1932 by 1910 pixels: 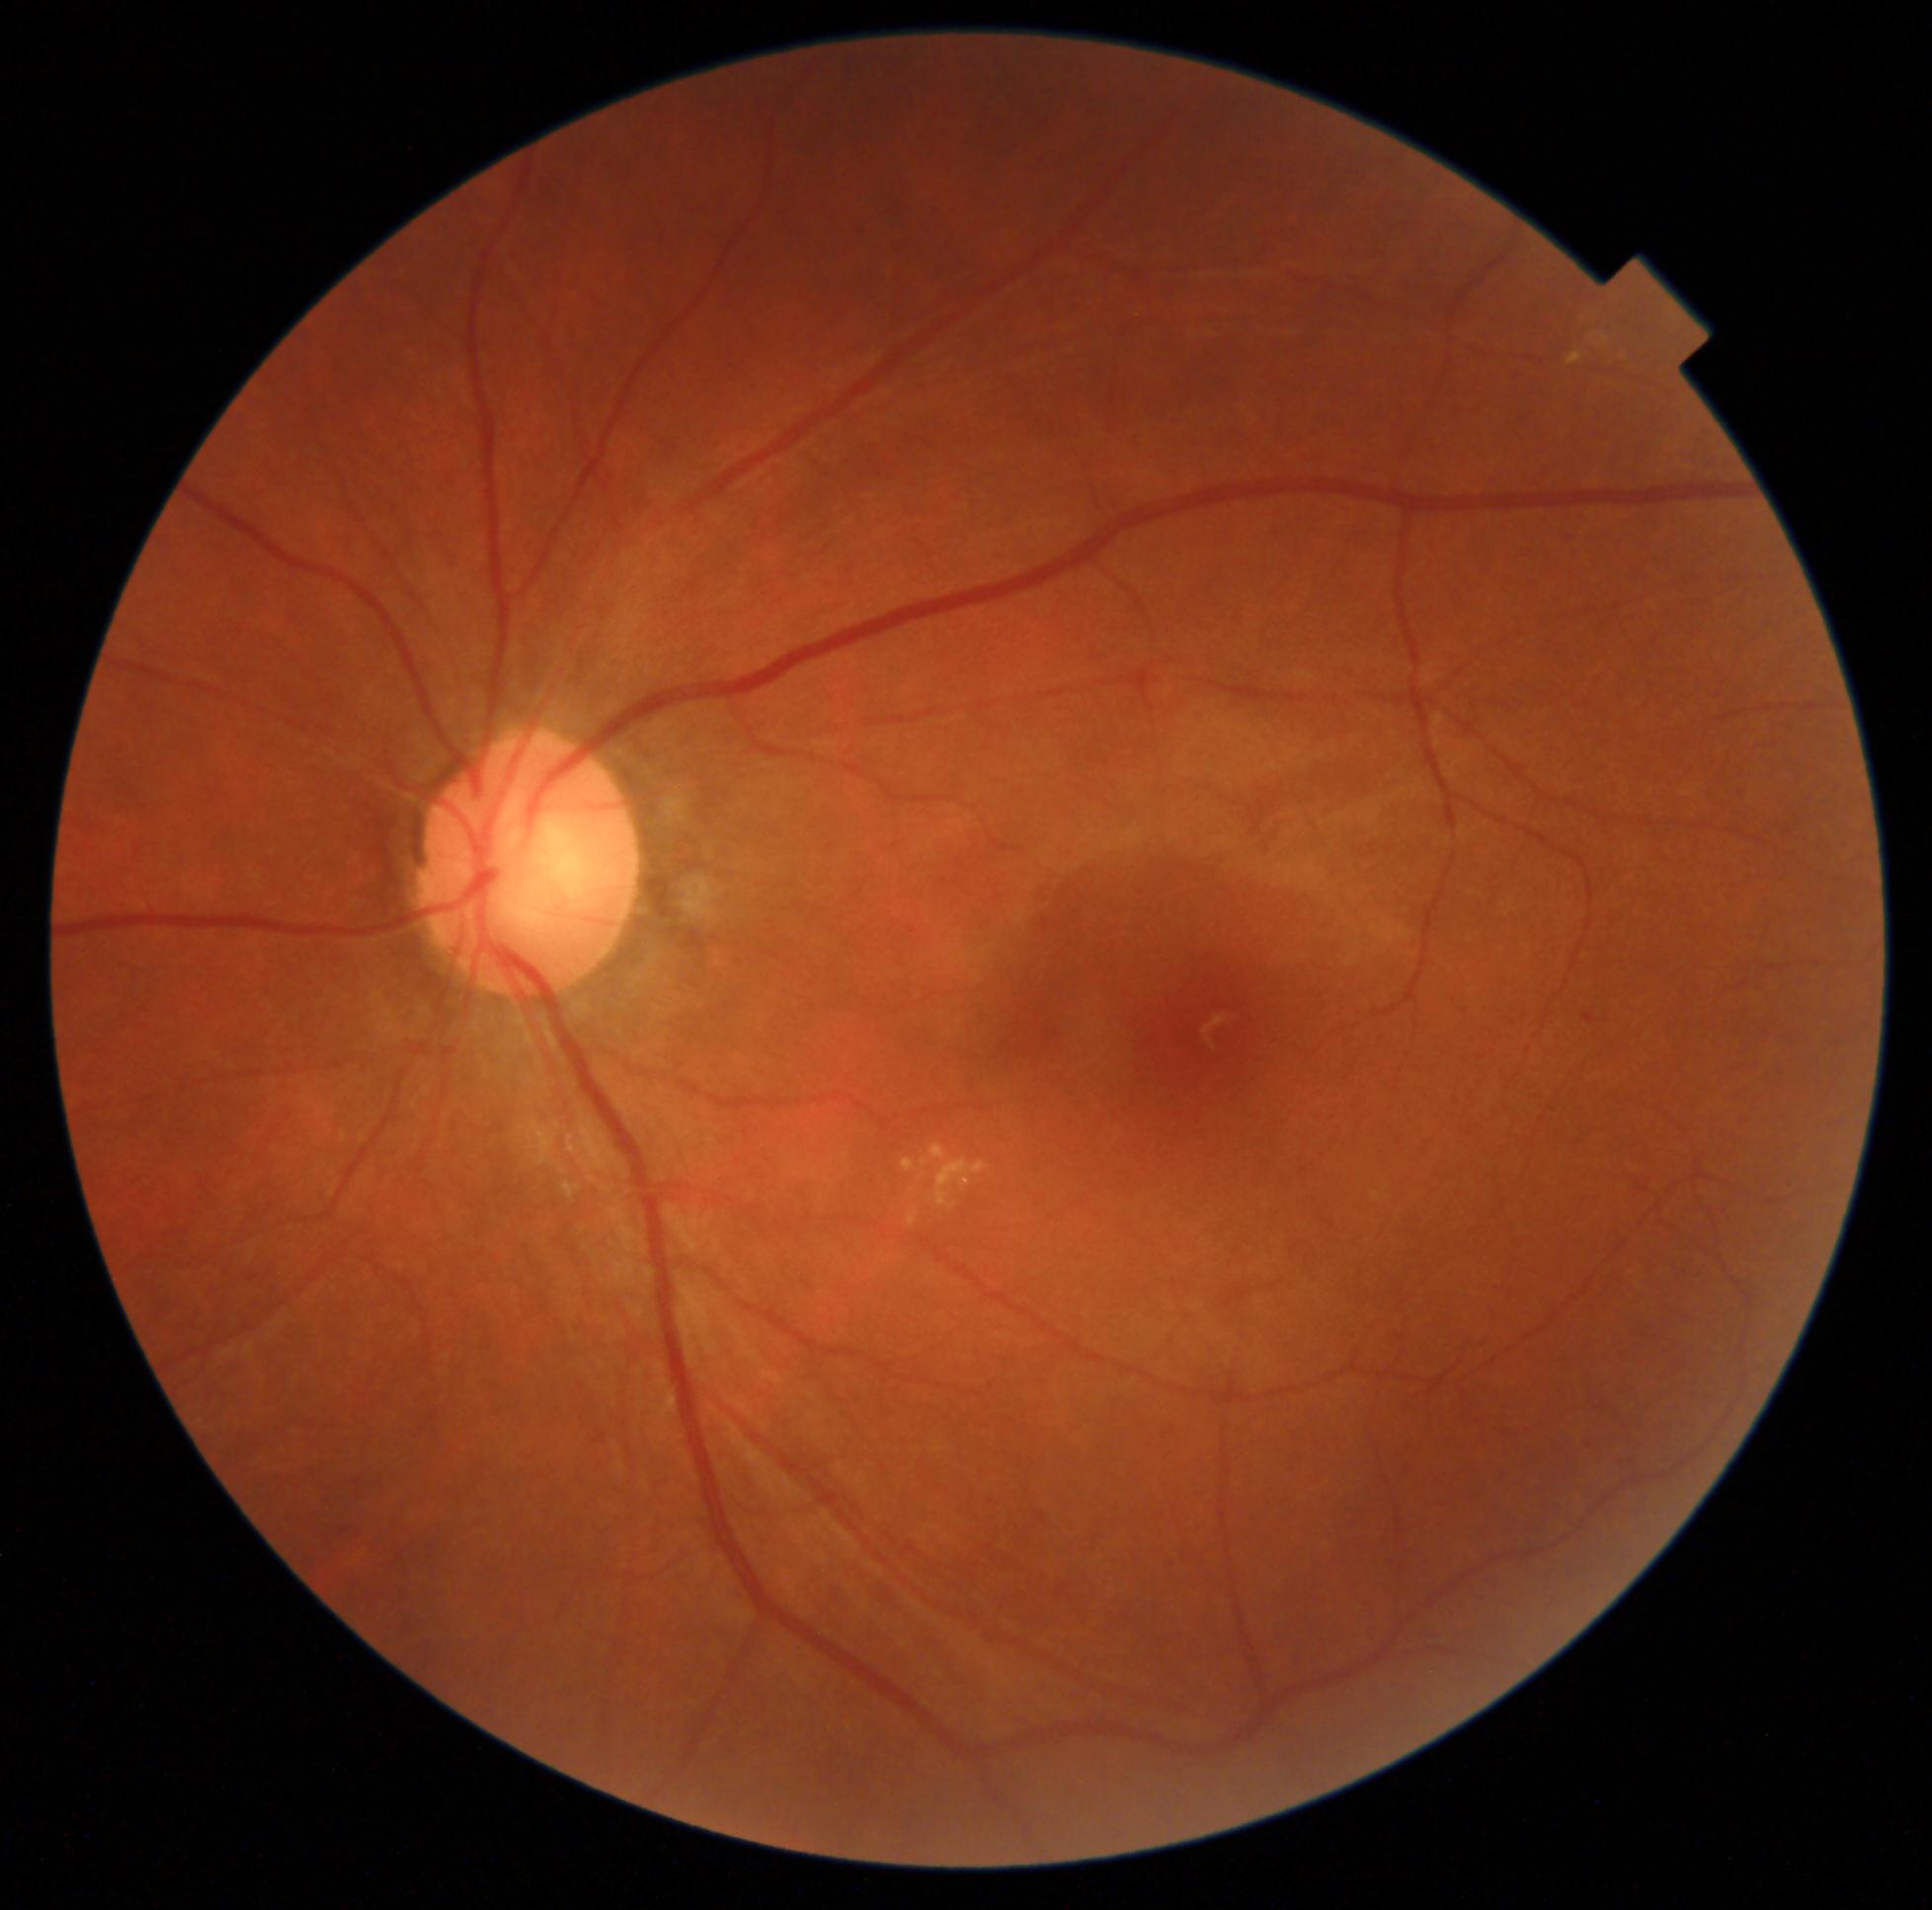
DR = grade 2 (moderate NPDR)